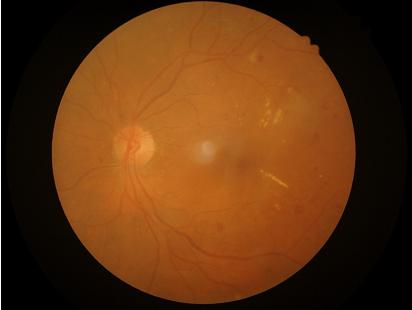

Image quality: sharpness: in focus | overall: adequate | illumination/color: adequate.